Fundus photo — 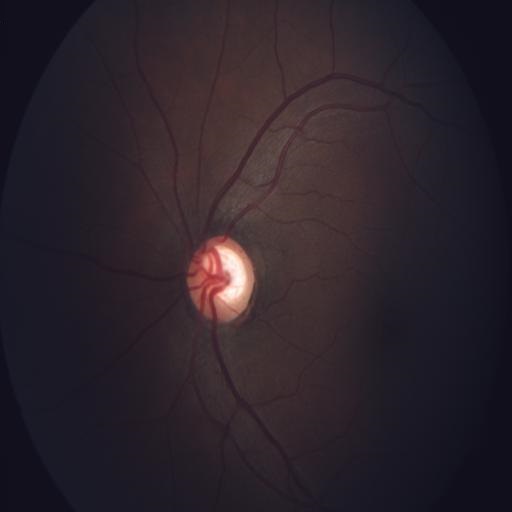

Impression:
- optic disc cupping